Wide-field fundus photograph from neonatal ROP screening · 640x480.
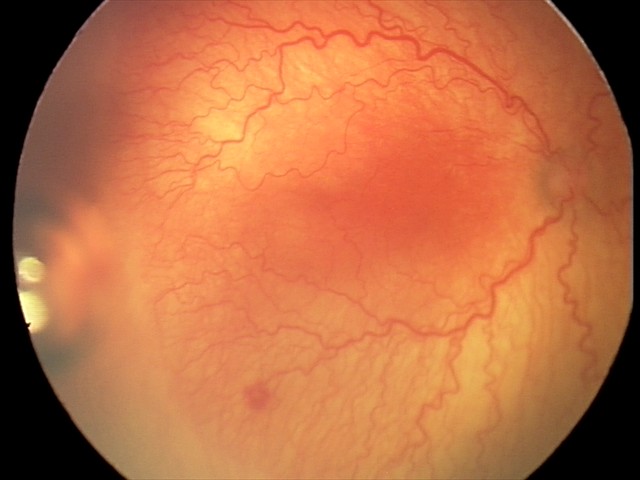

Series diagnosed as aggressive ROP (A-ROP).
With plus disease.